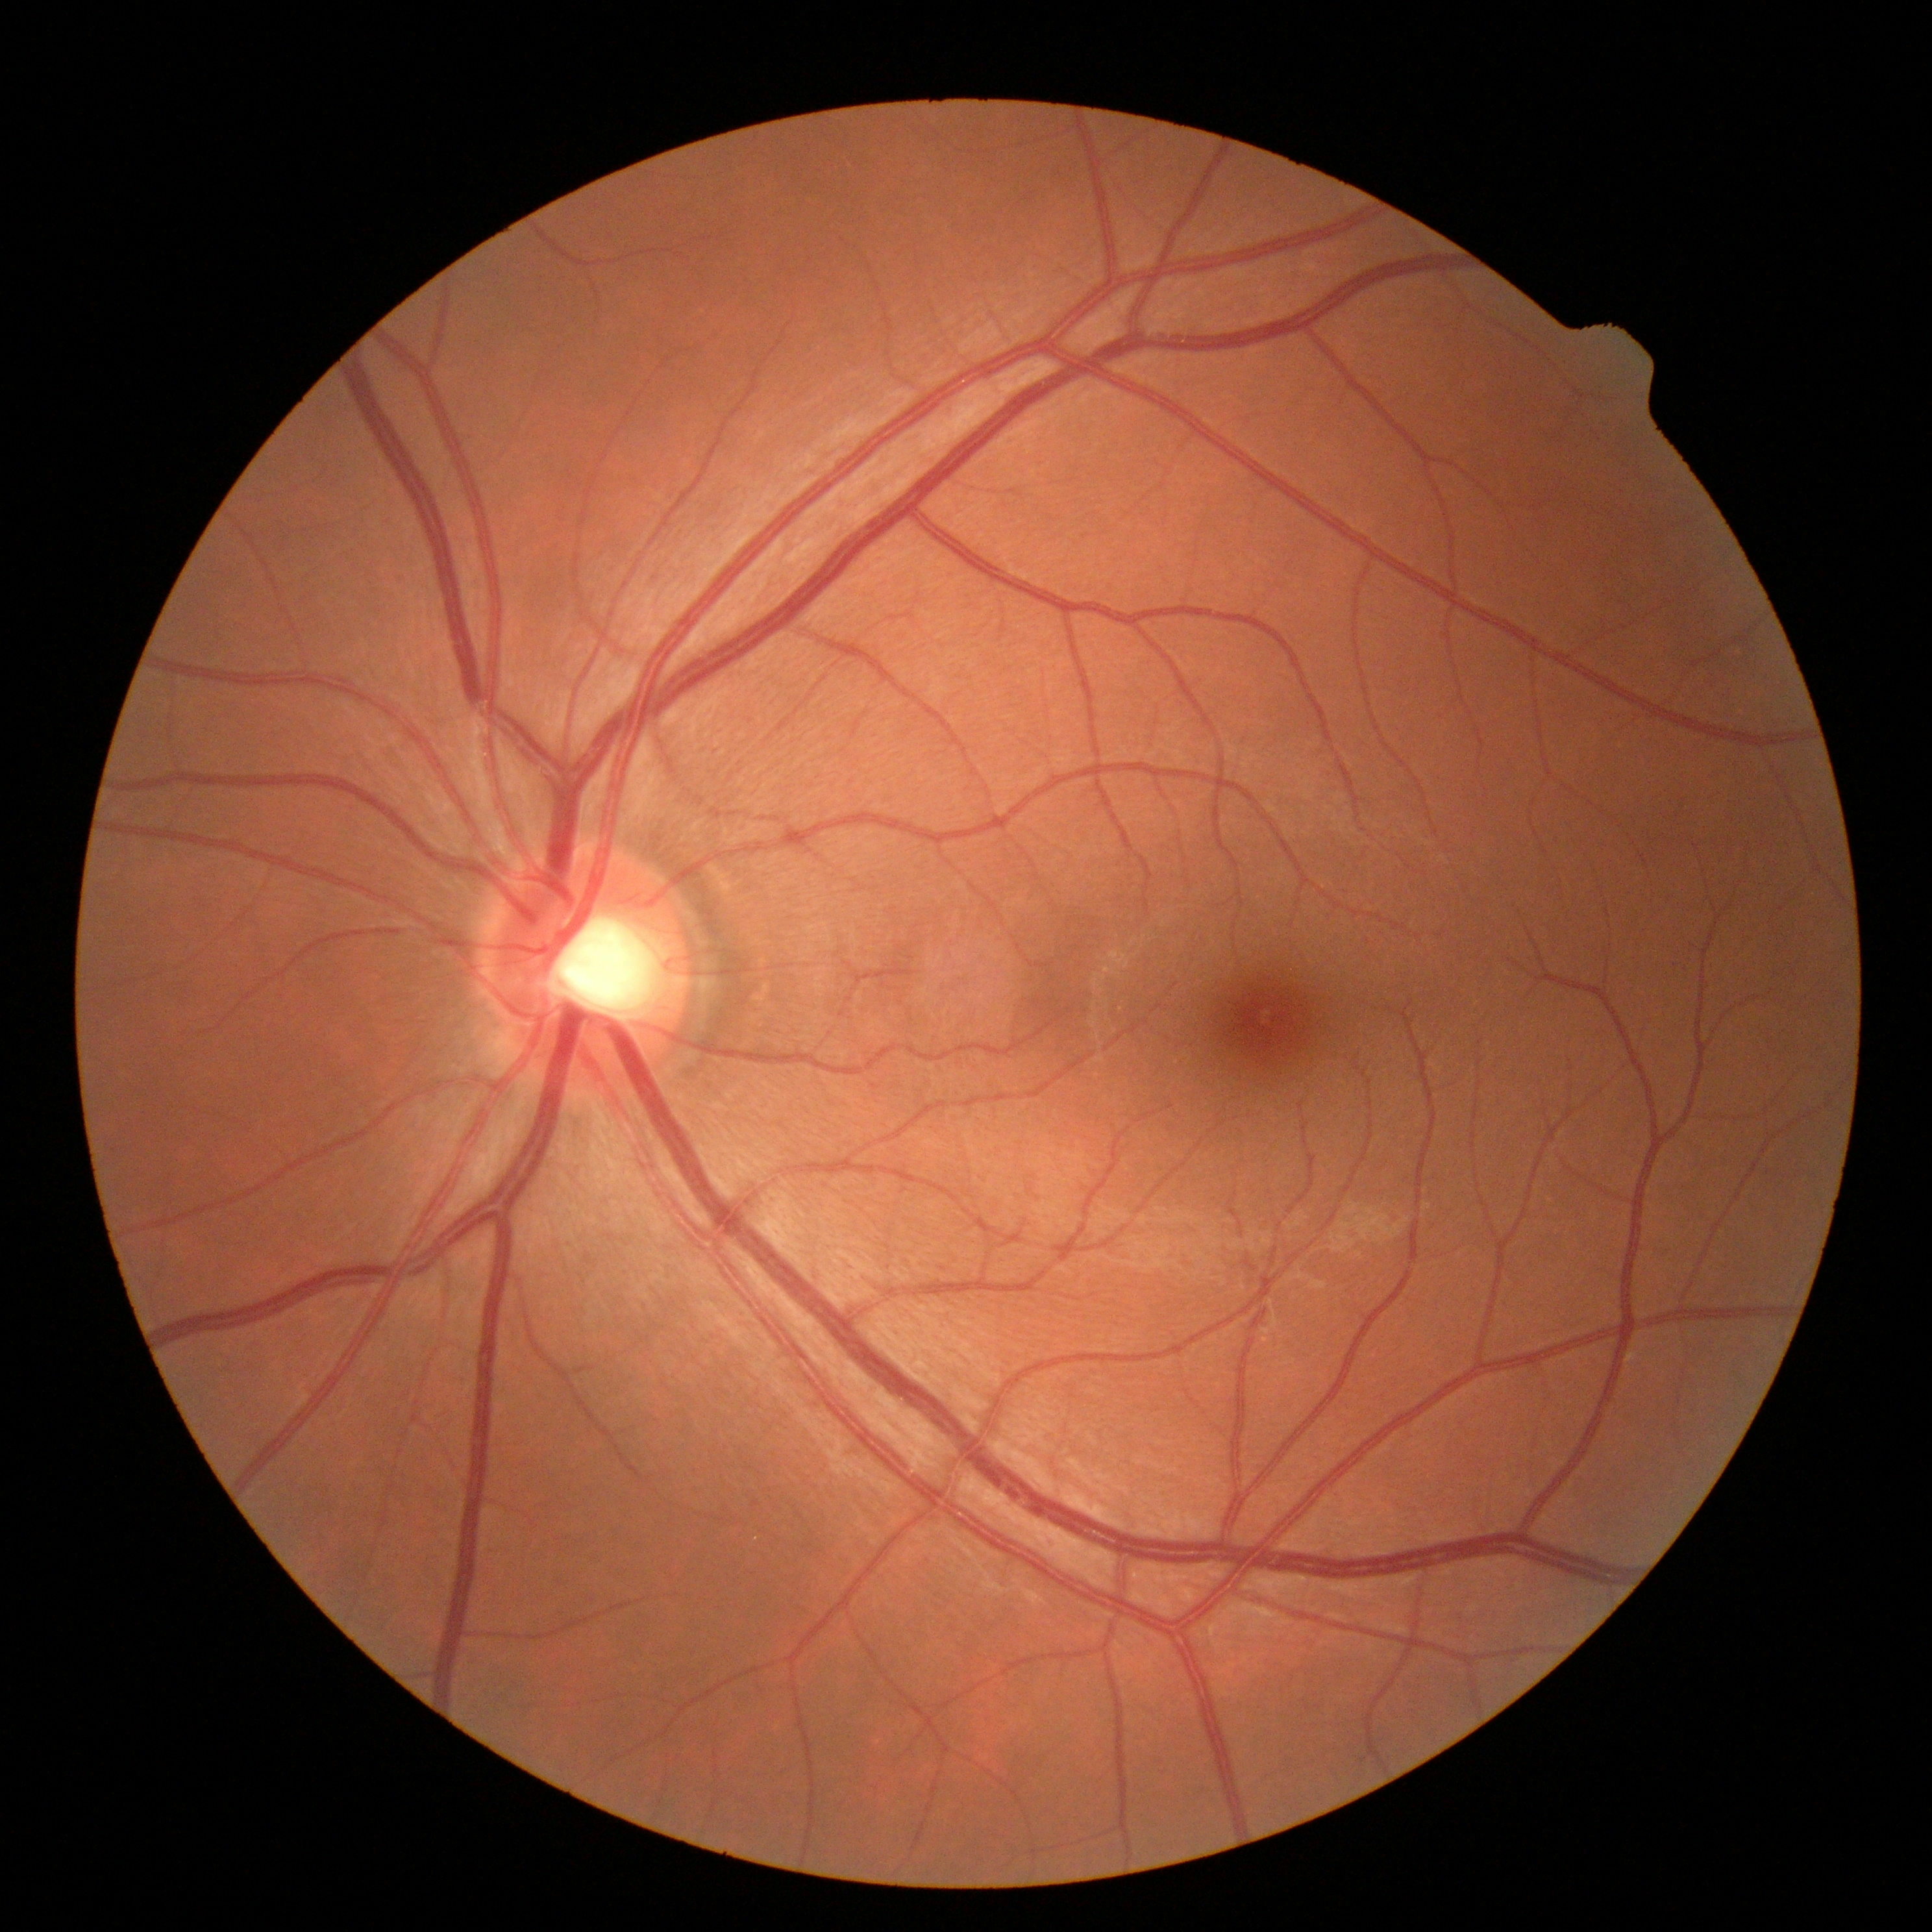 DR severity = no apparent diabetic retinopathy (grade 0) — no visible signs of diabetic retinopathy.